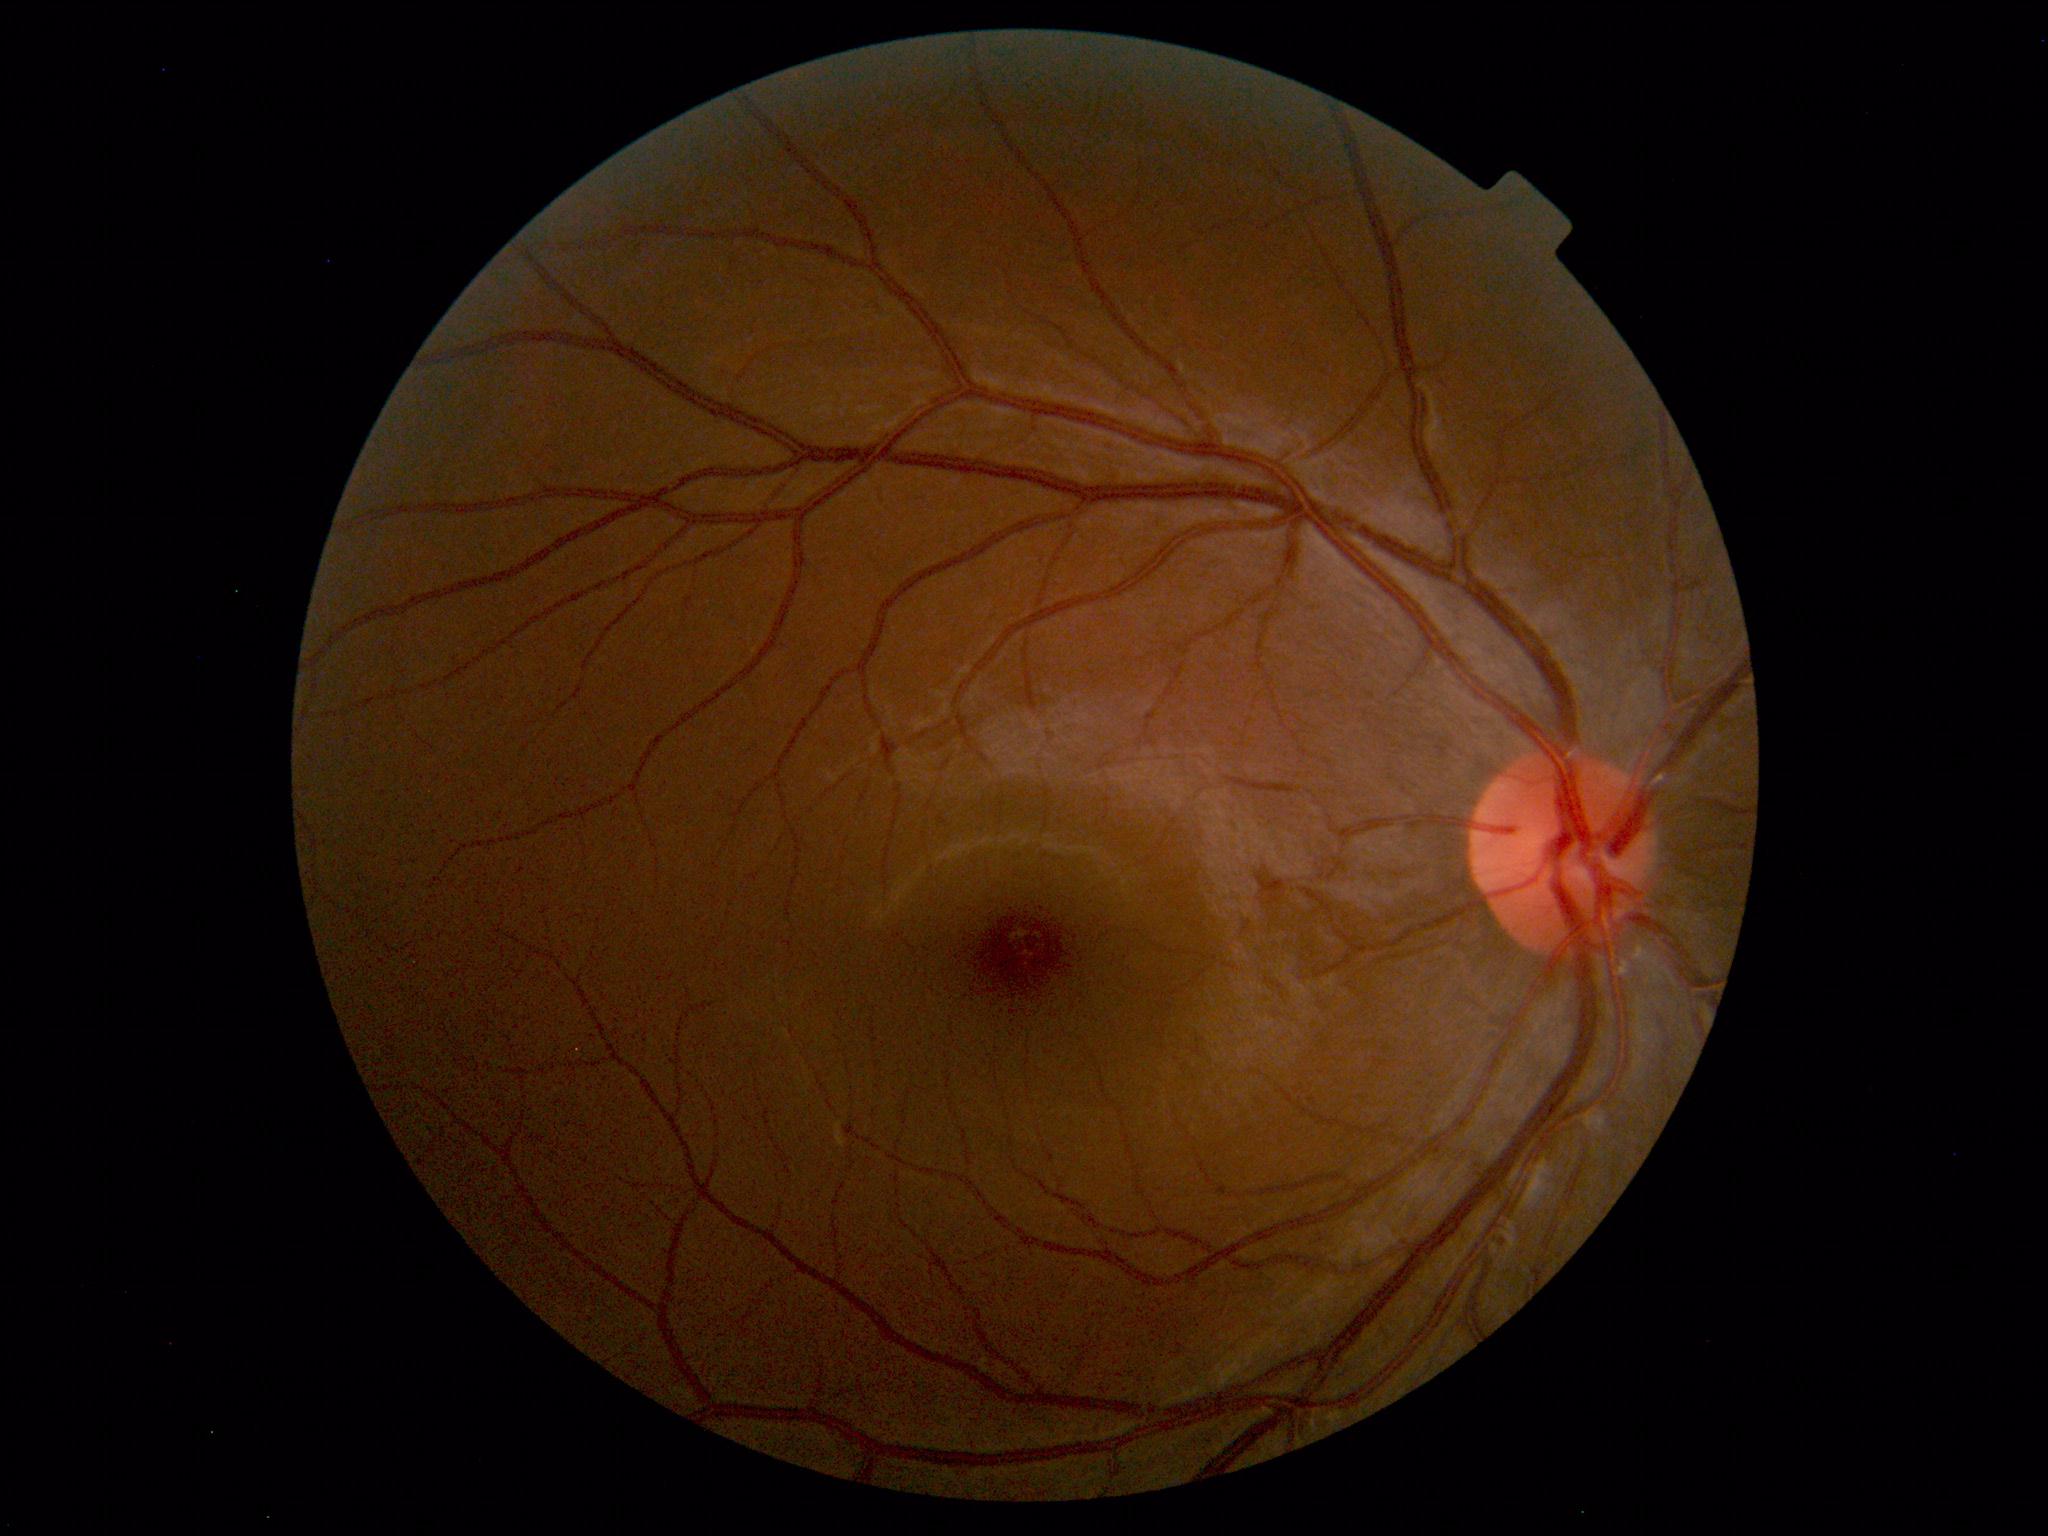

Unremarkable color fundus photograph.